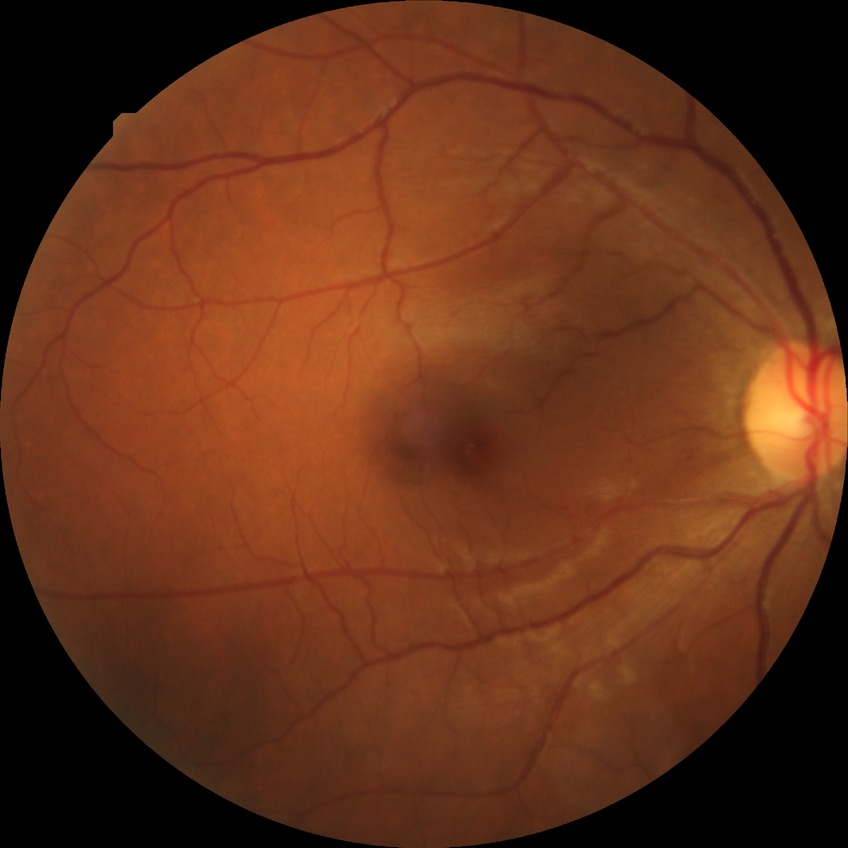 Diabetic retinopathy (DR) is NDR (no diabetic retinopathy).